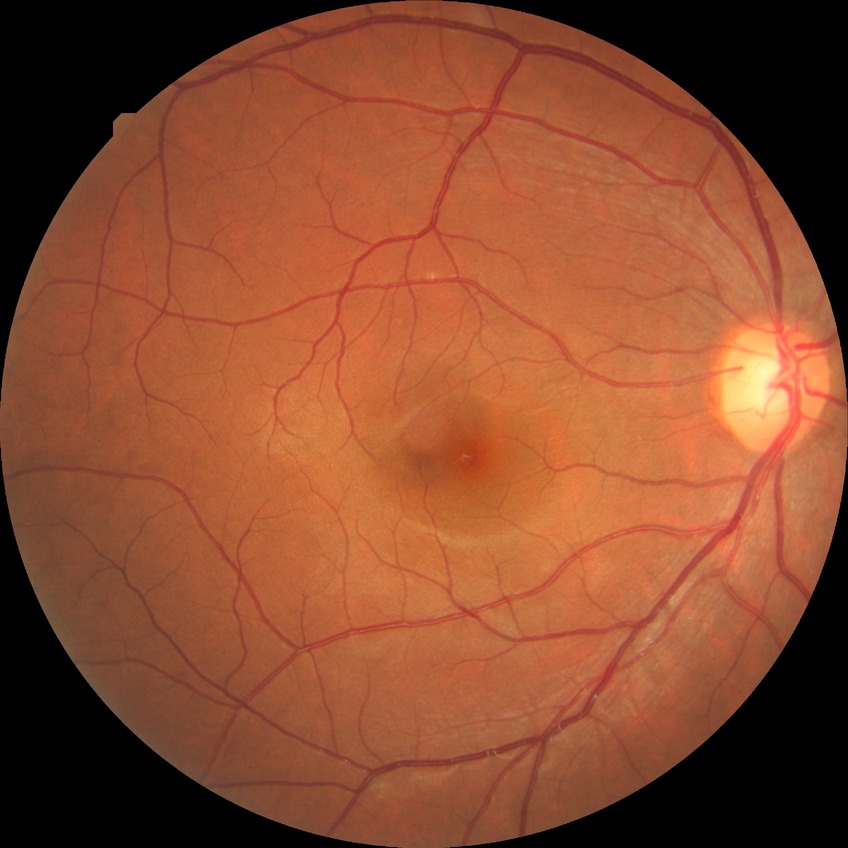
Diabetic retinopathy (DR) is NDR (no diabetic retinopathy).